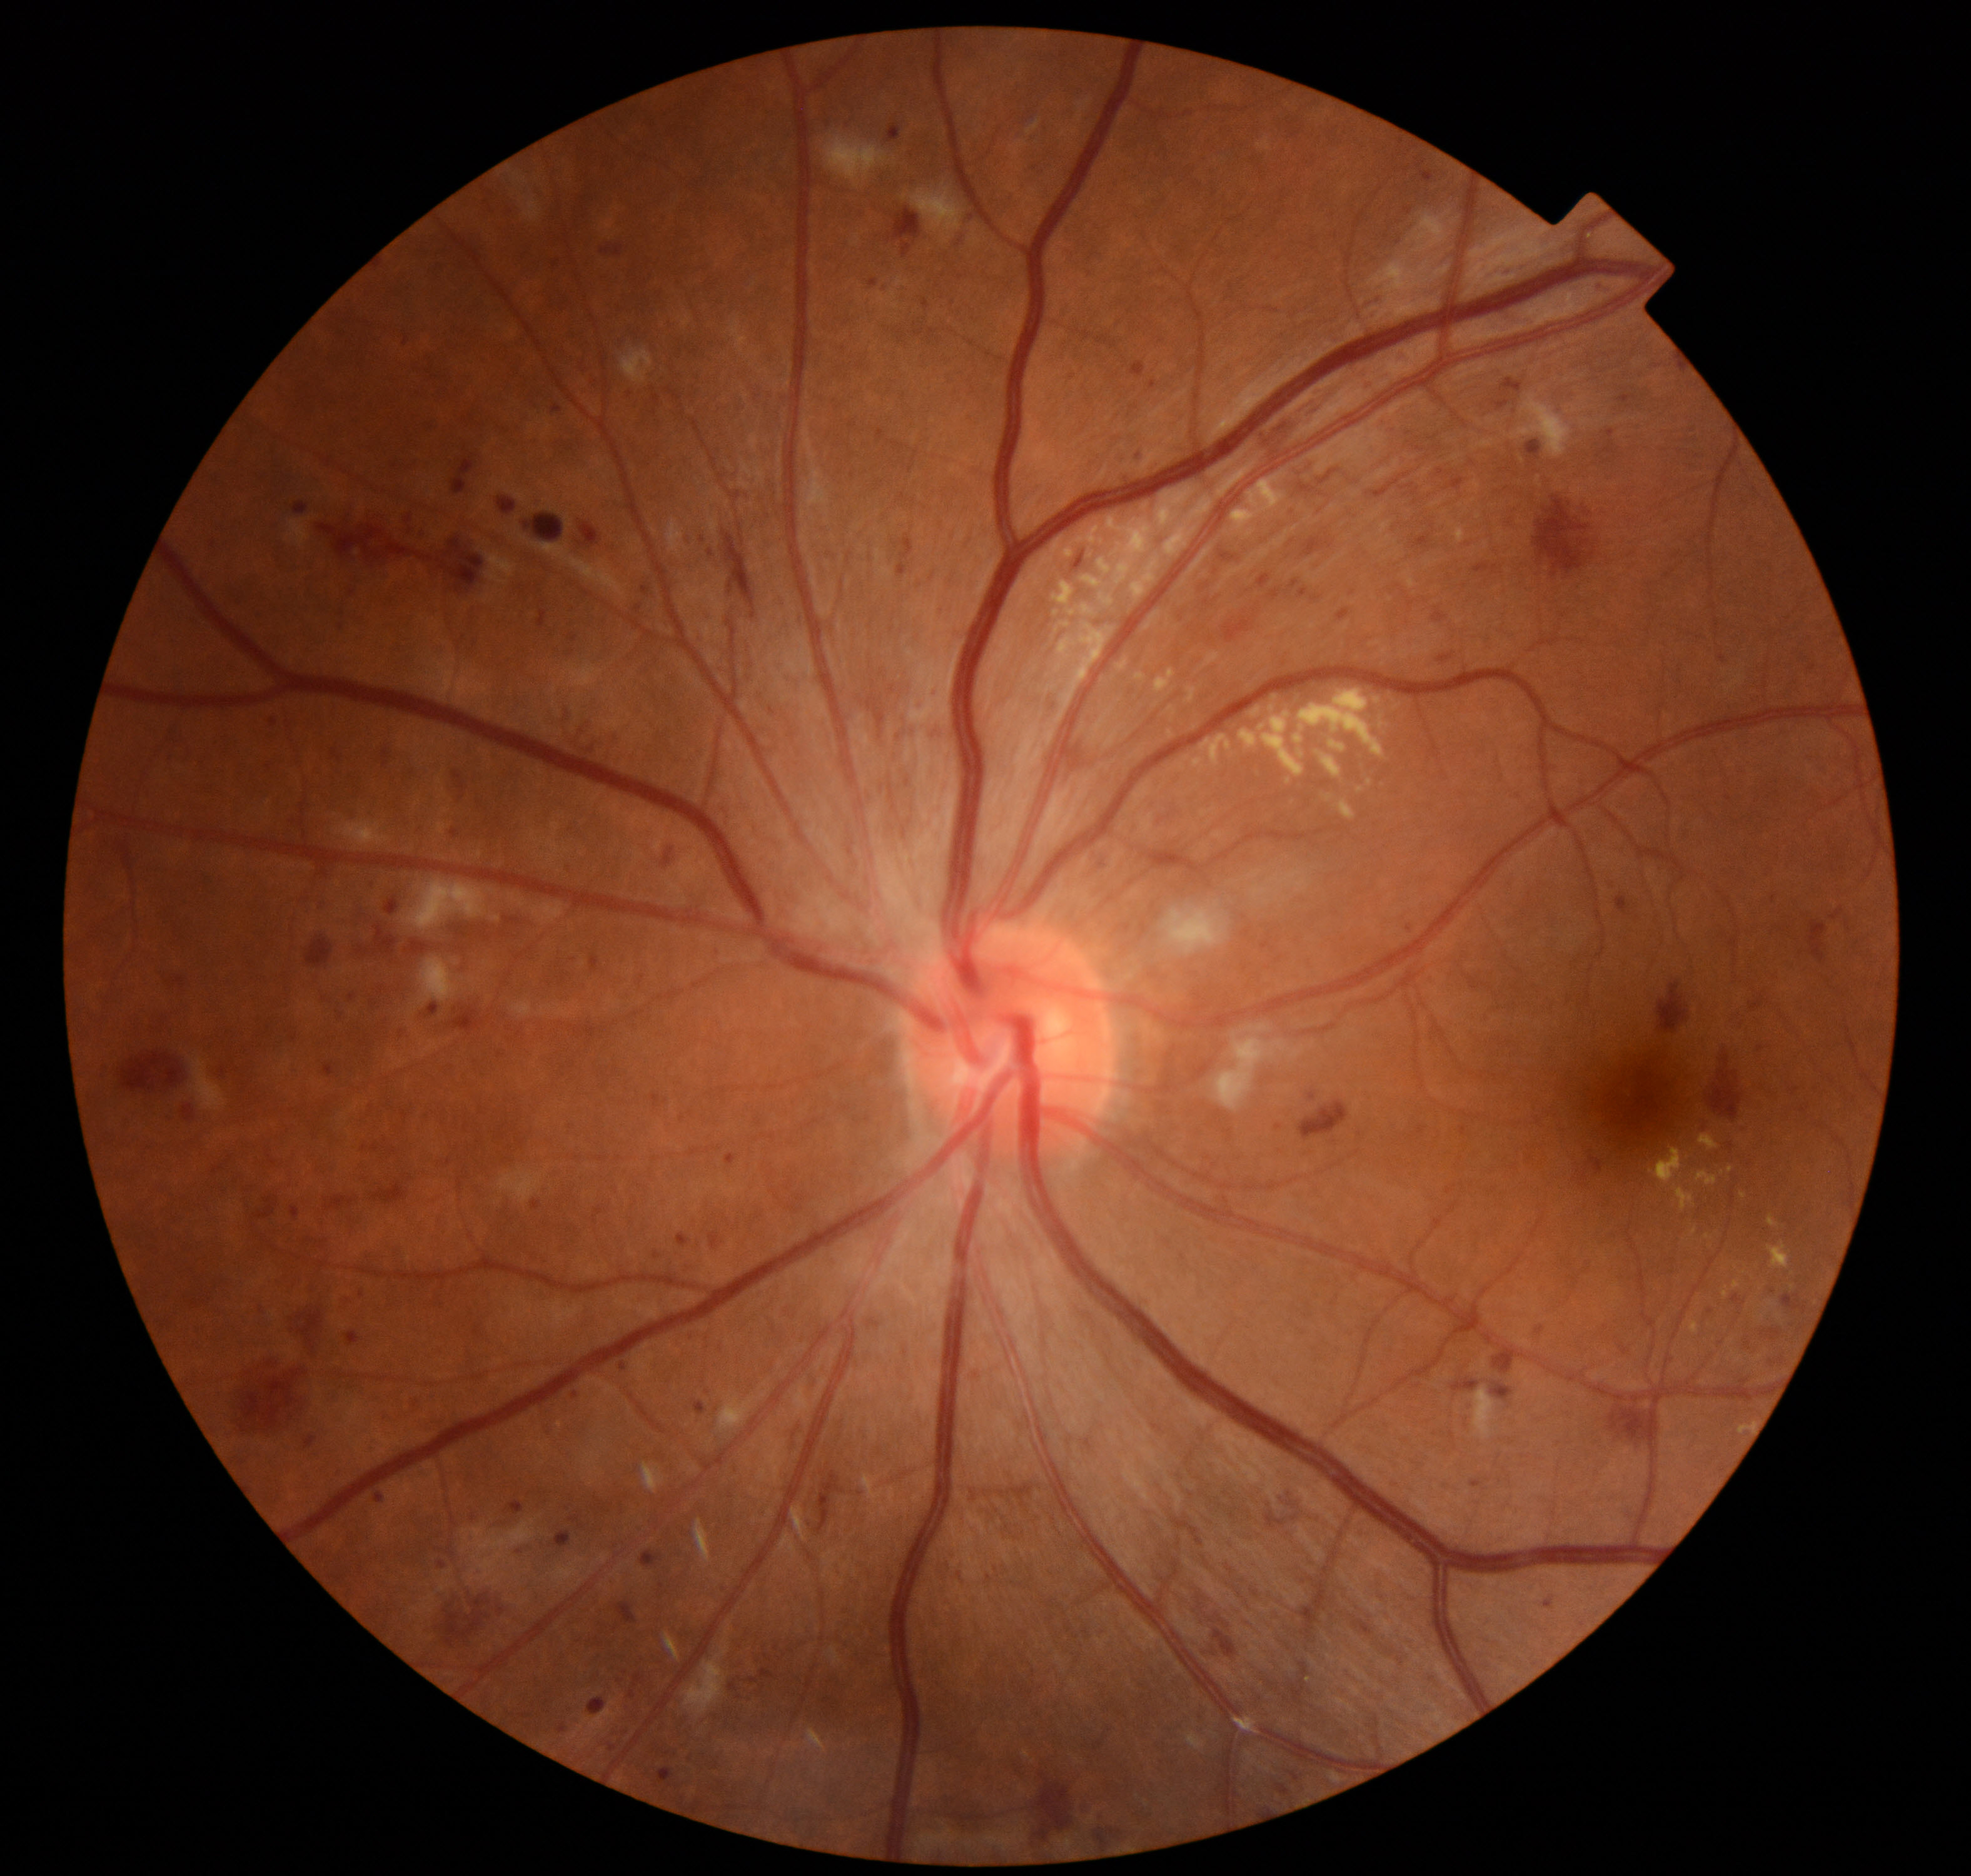 Impression: moderate non-proliferative diabetic retinopathy.